Sex: F. Axial length: 23.46 mm. Age 67. Autorefraction: sphere +1 D, cylinder -0.5 D, axis 130°. Central corneal thickness 467 µm. Intraocular pressure: 12 mmHg
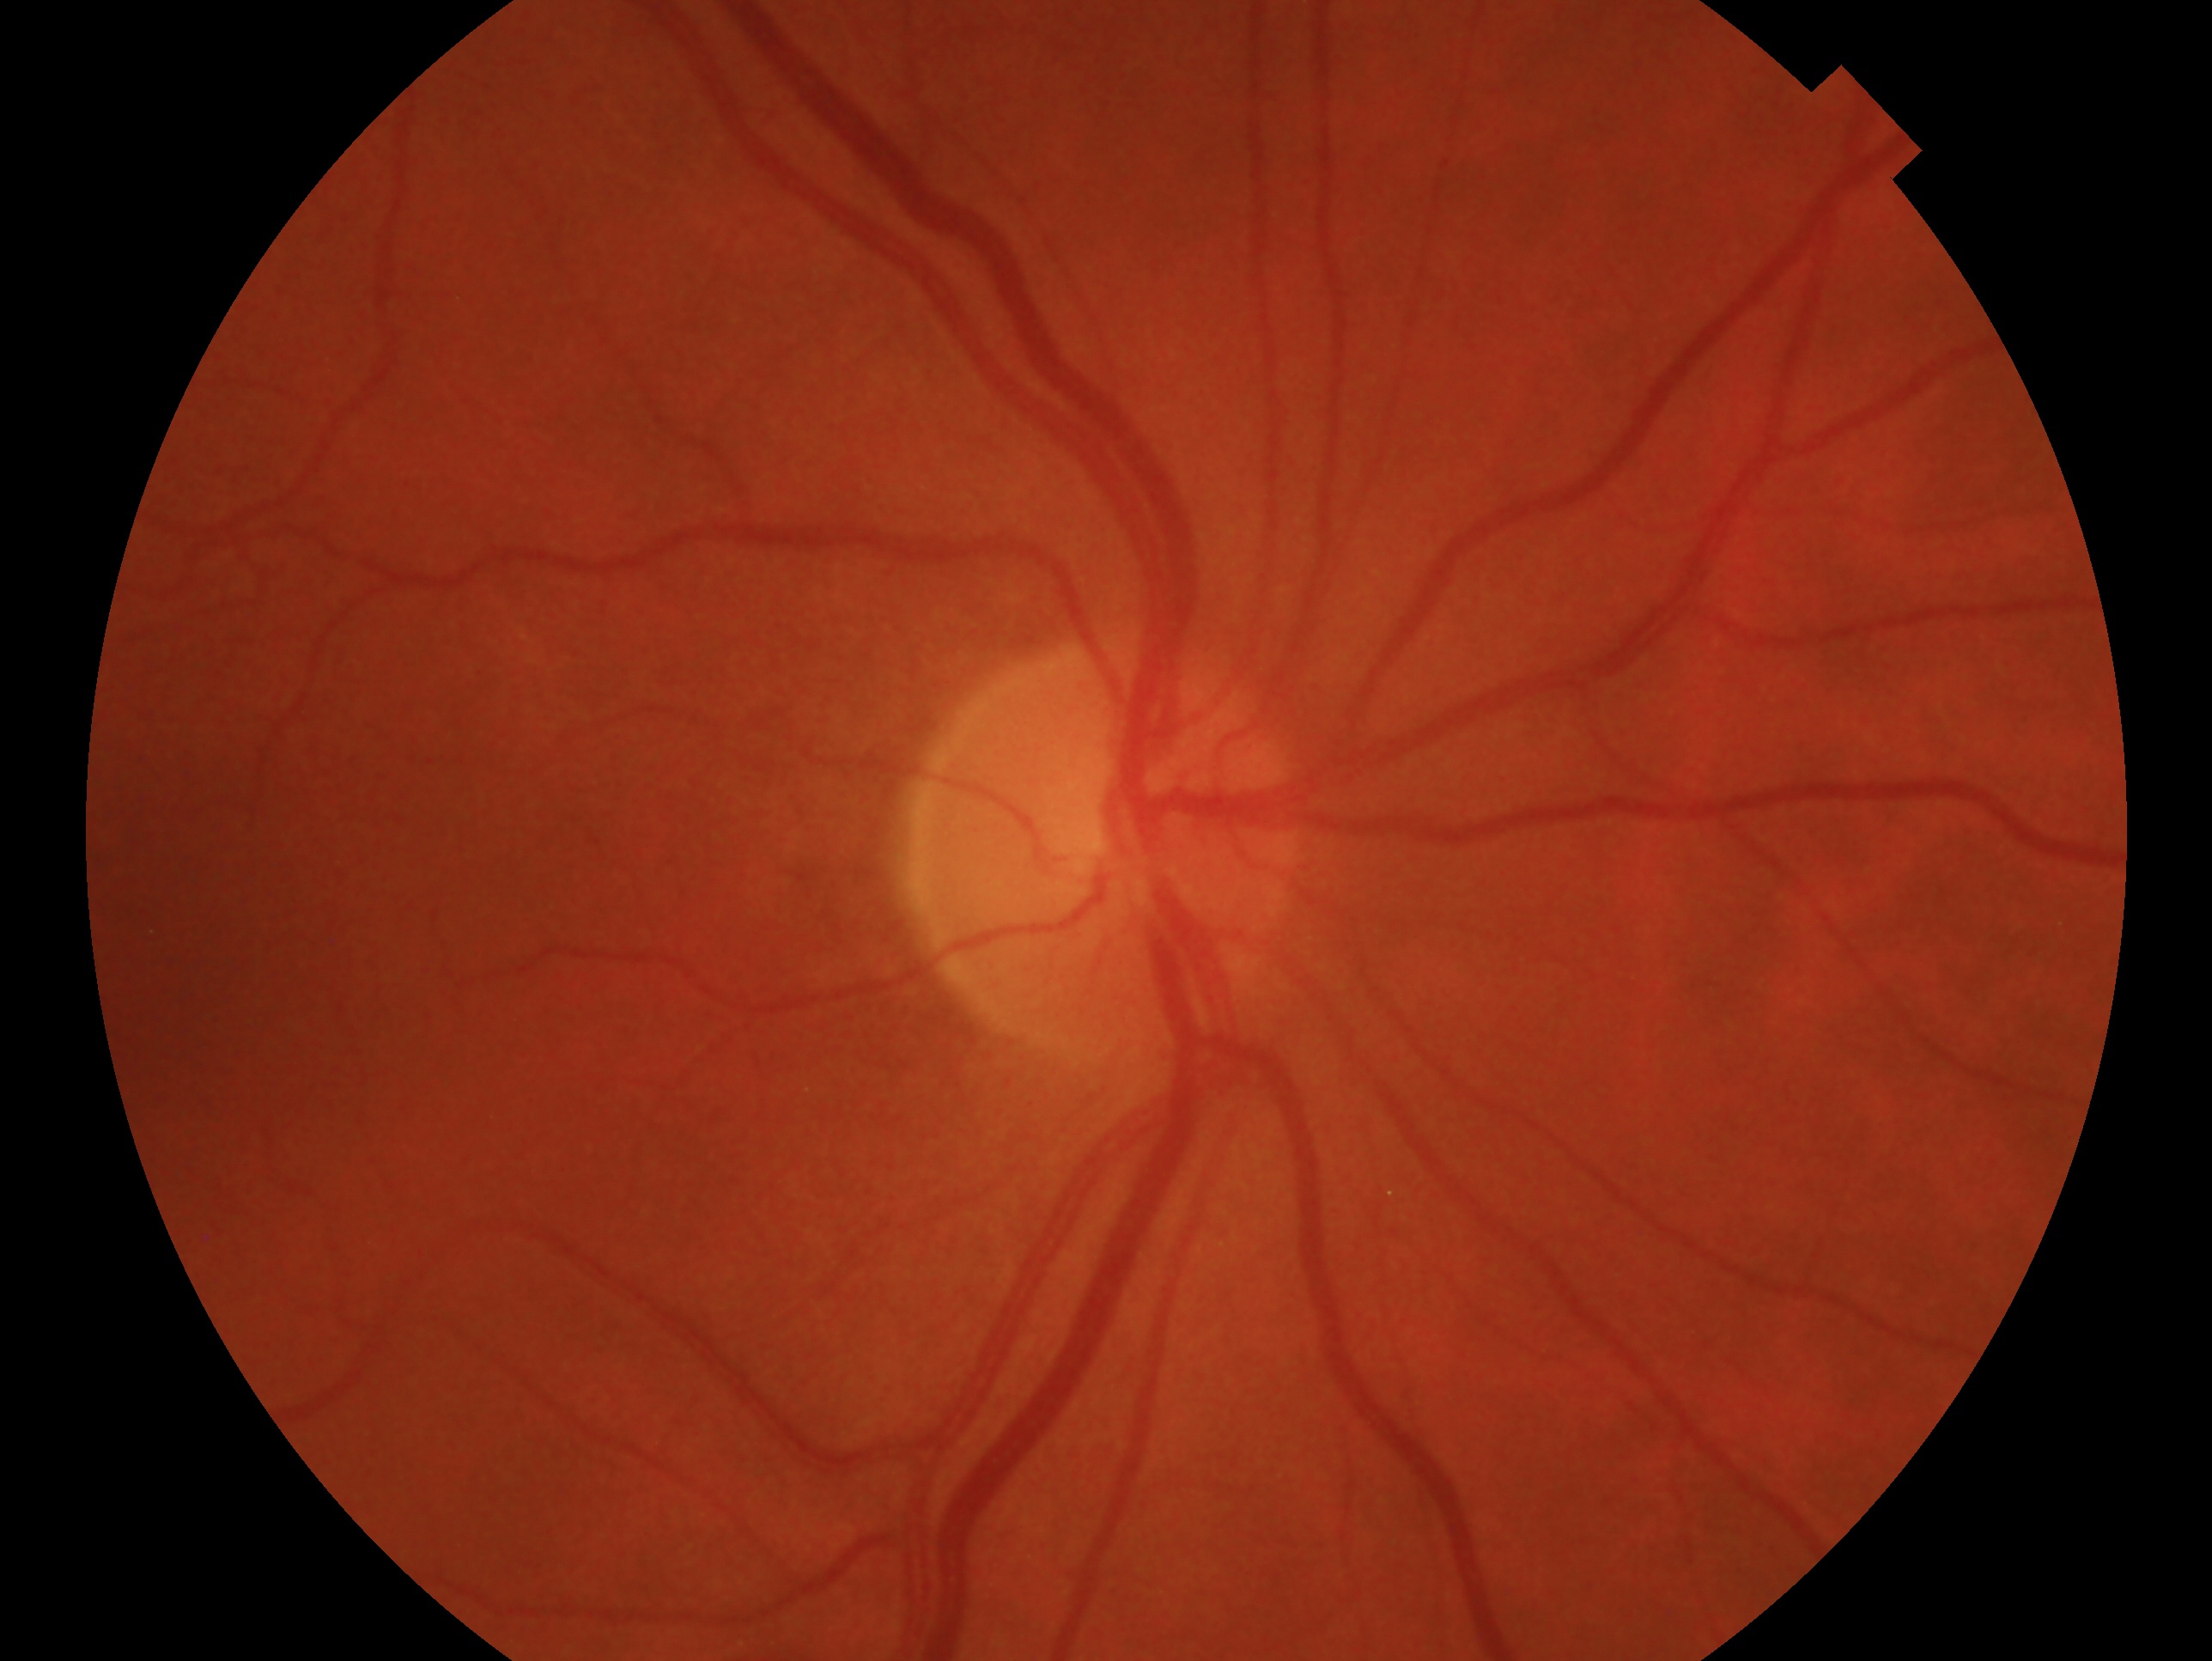

Diagnosis: no glaucoma.
Eye: right eye.